DR severity per modified Davis staging · 45-degree field of view · nonmydriatic
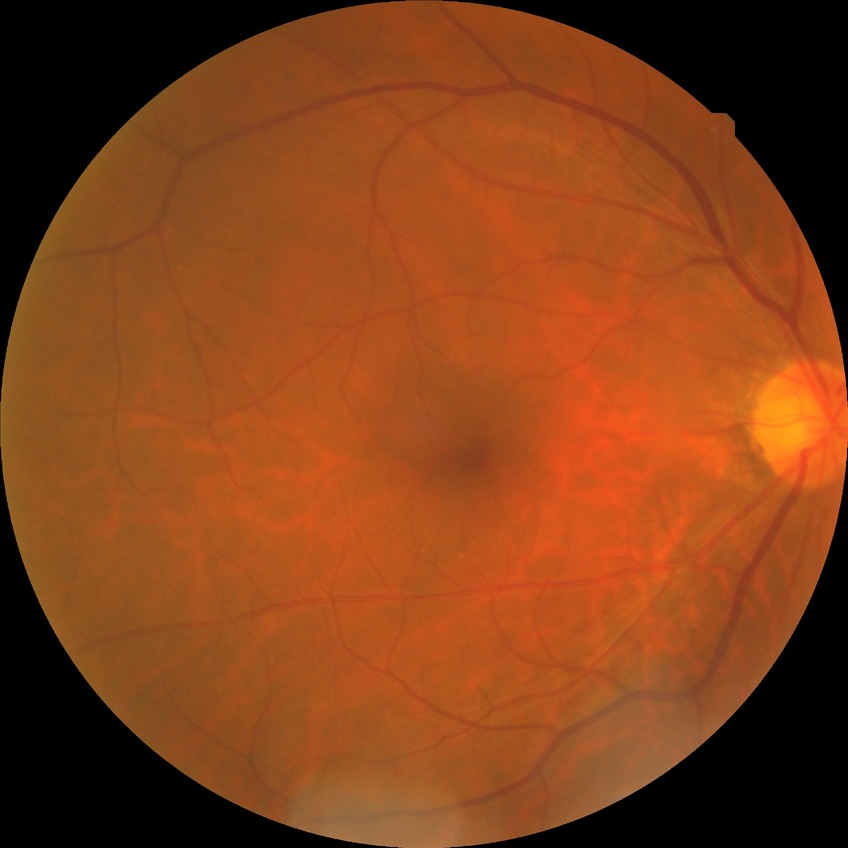

diabetic retinopathy (DR) = no diabetic retinopathy (NDR)